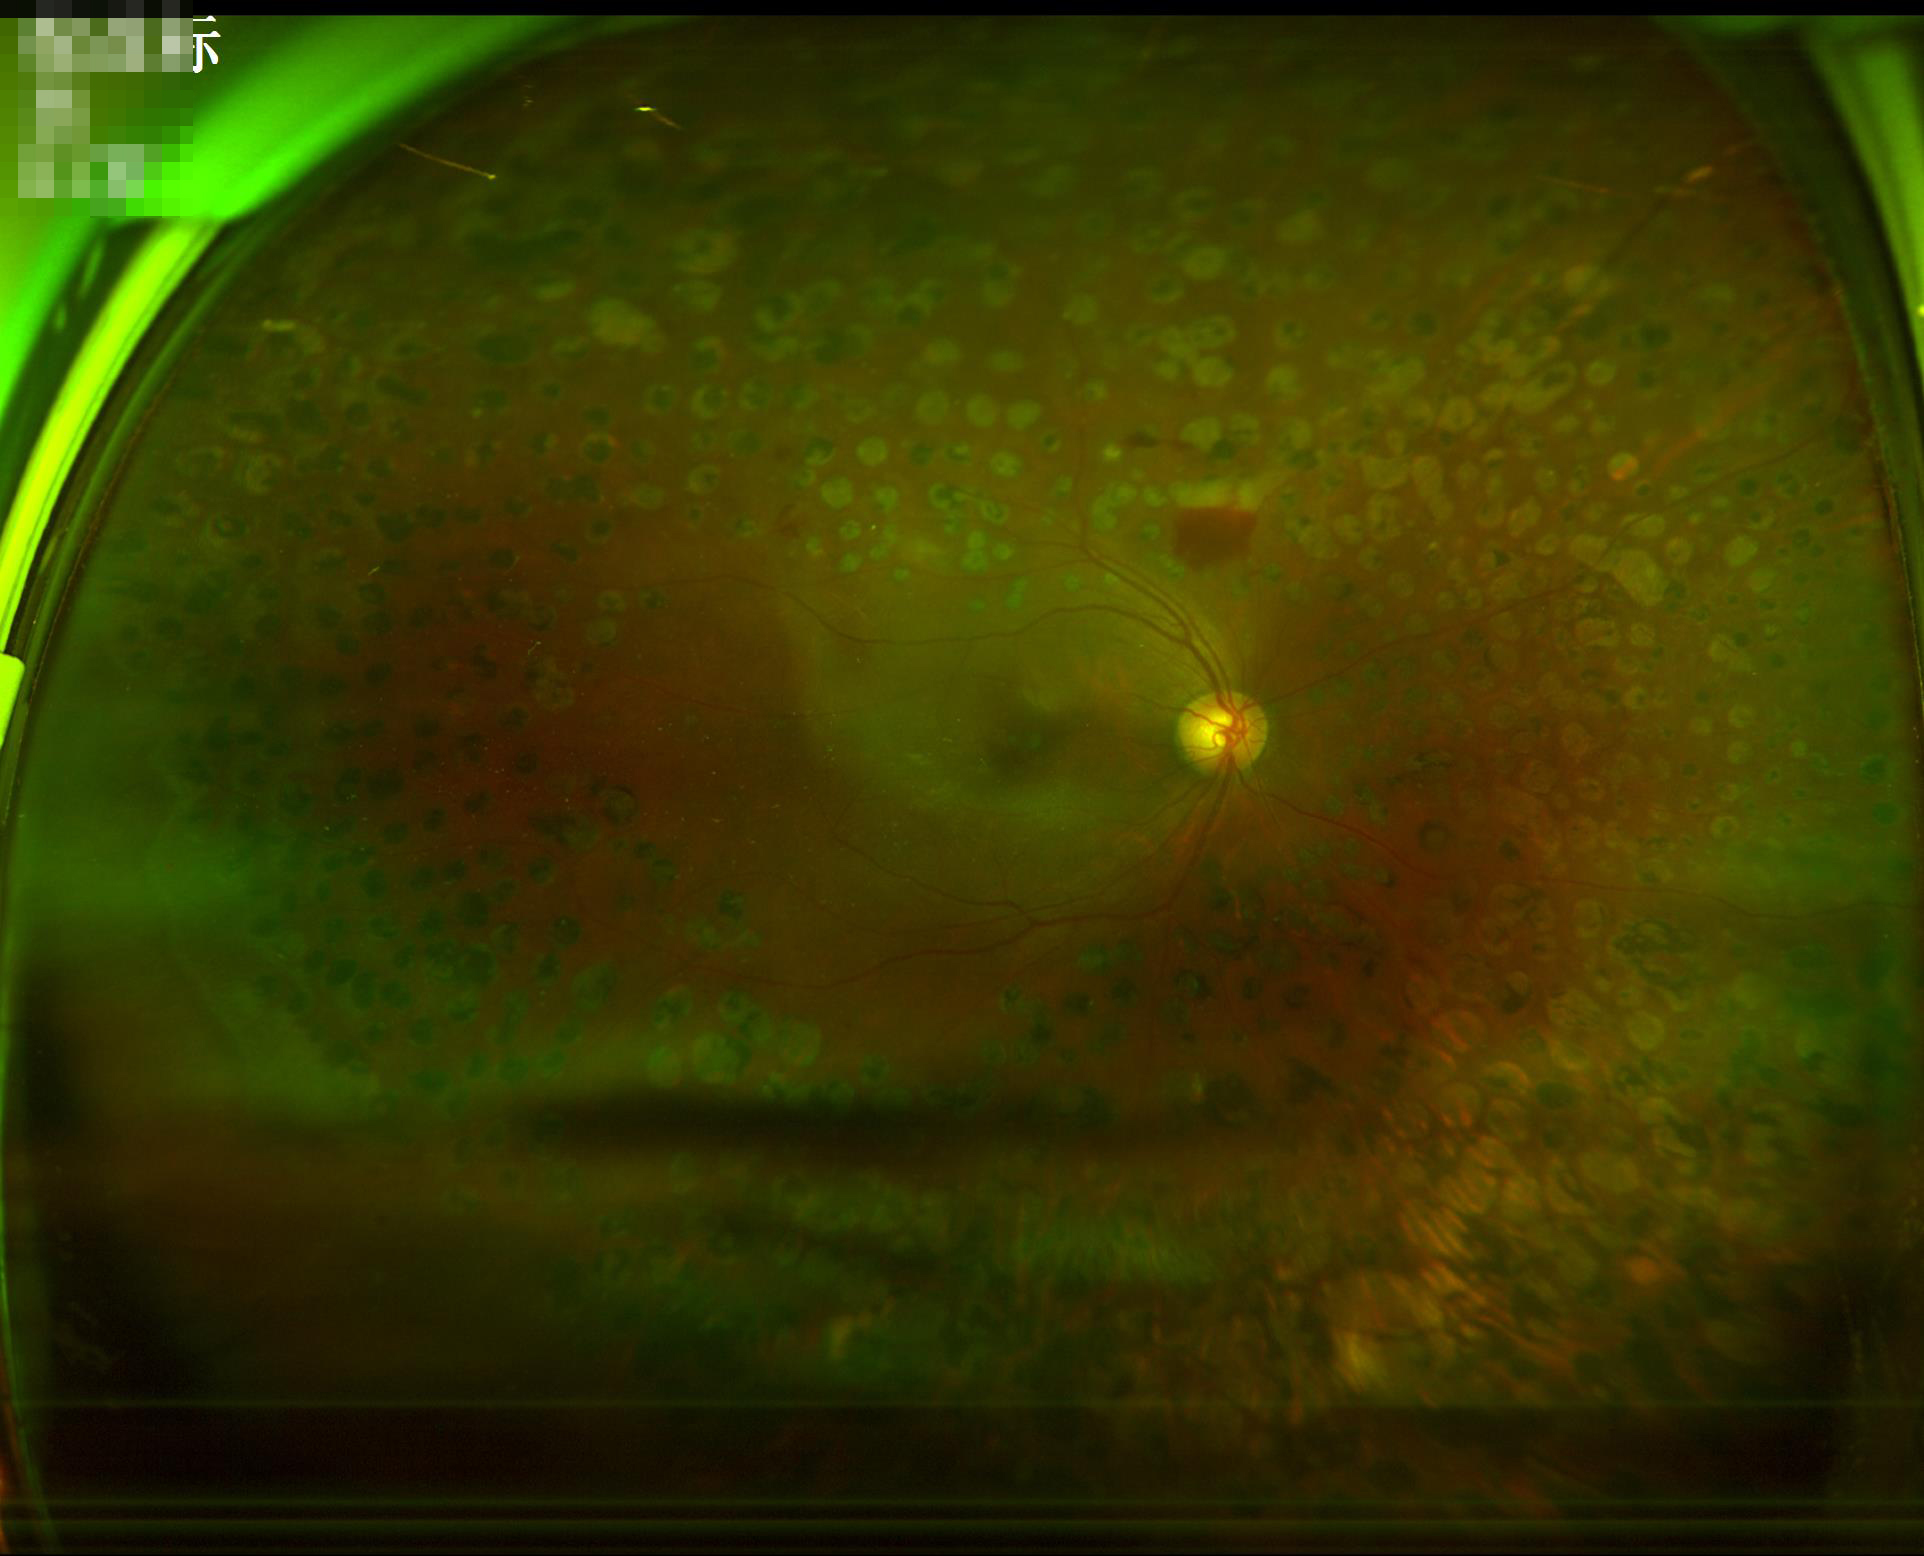

contrast: good dynamic range
illumination: uneven illumination or color cast
overall_quality: poor and difficult to use diagnostically
clarity: reduced sharpness with visible blur